1659 by 2212 pixels.
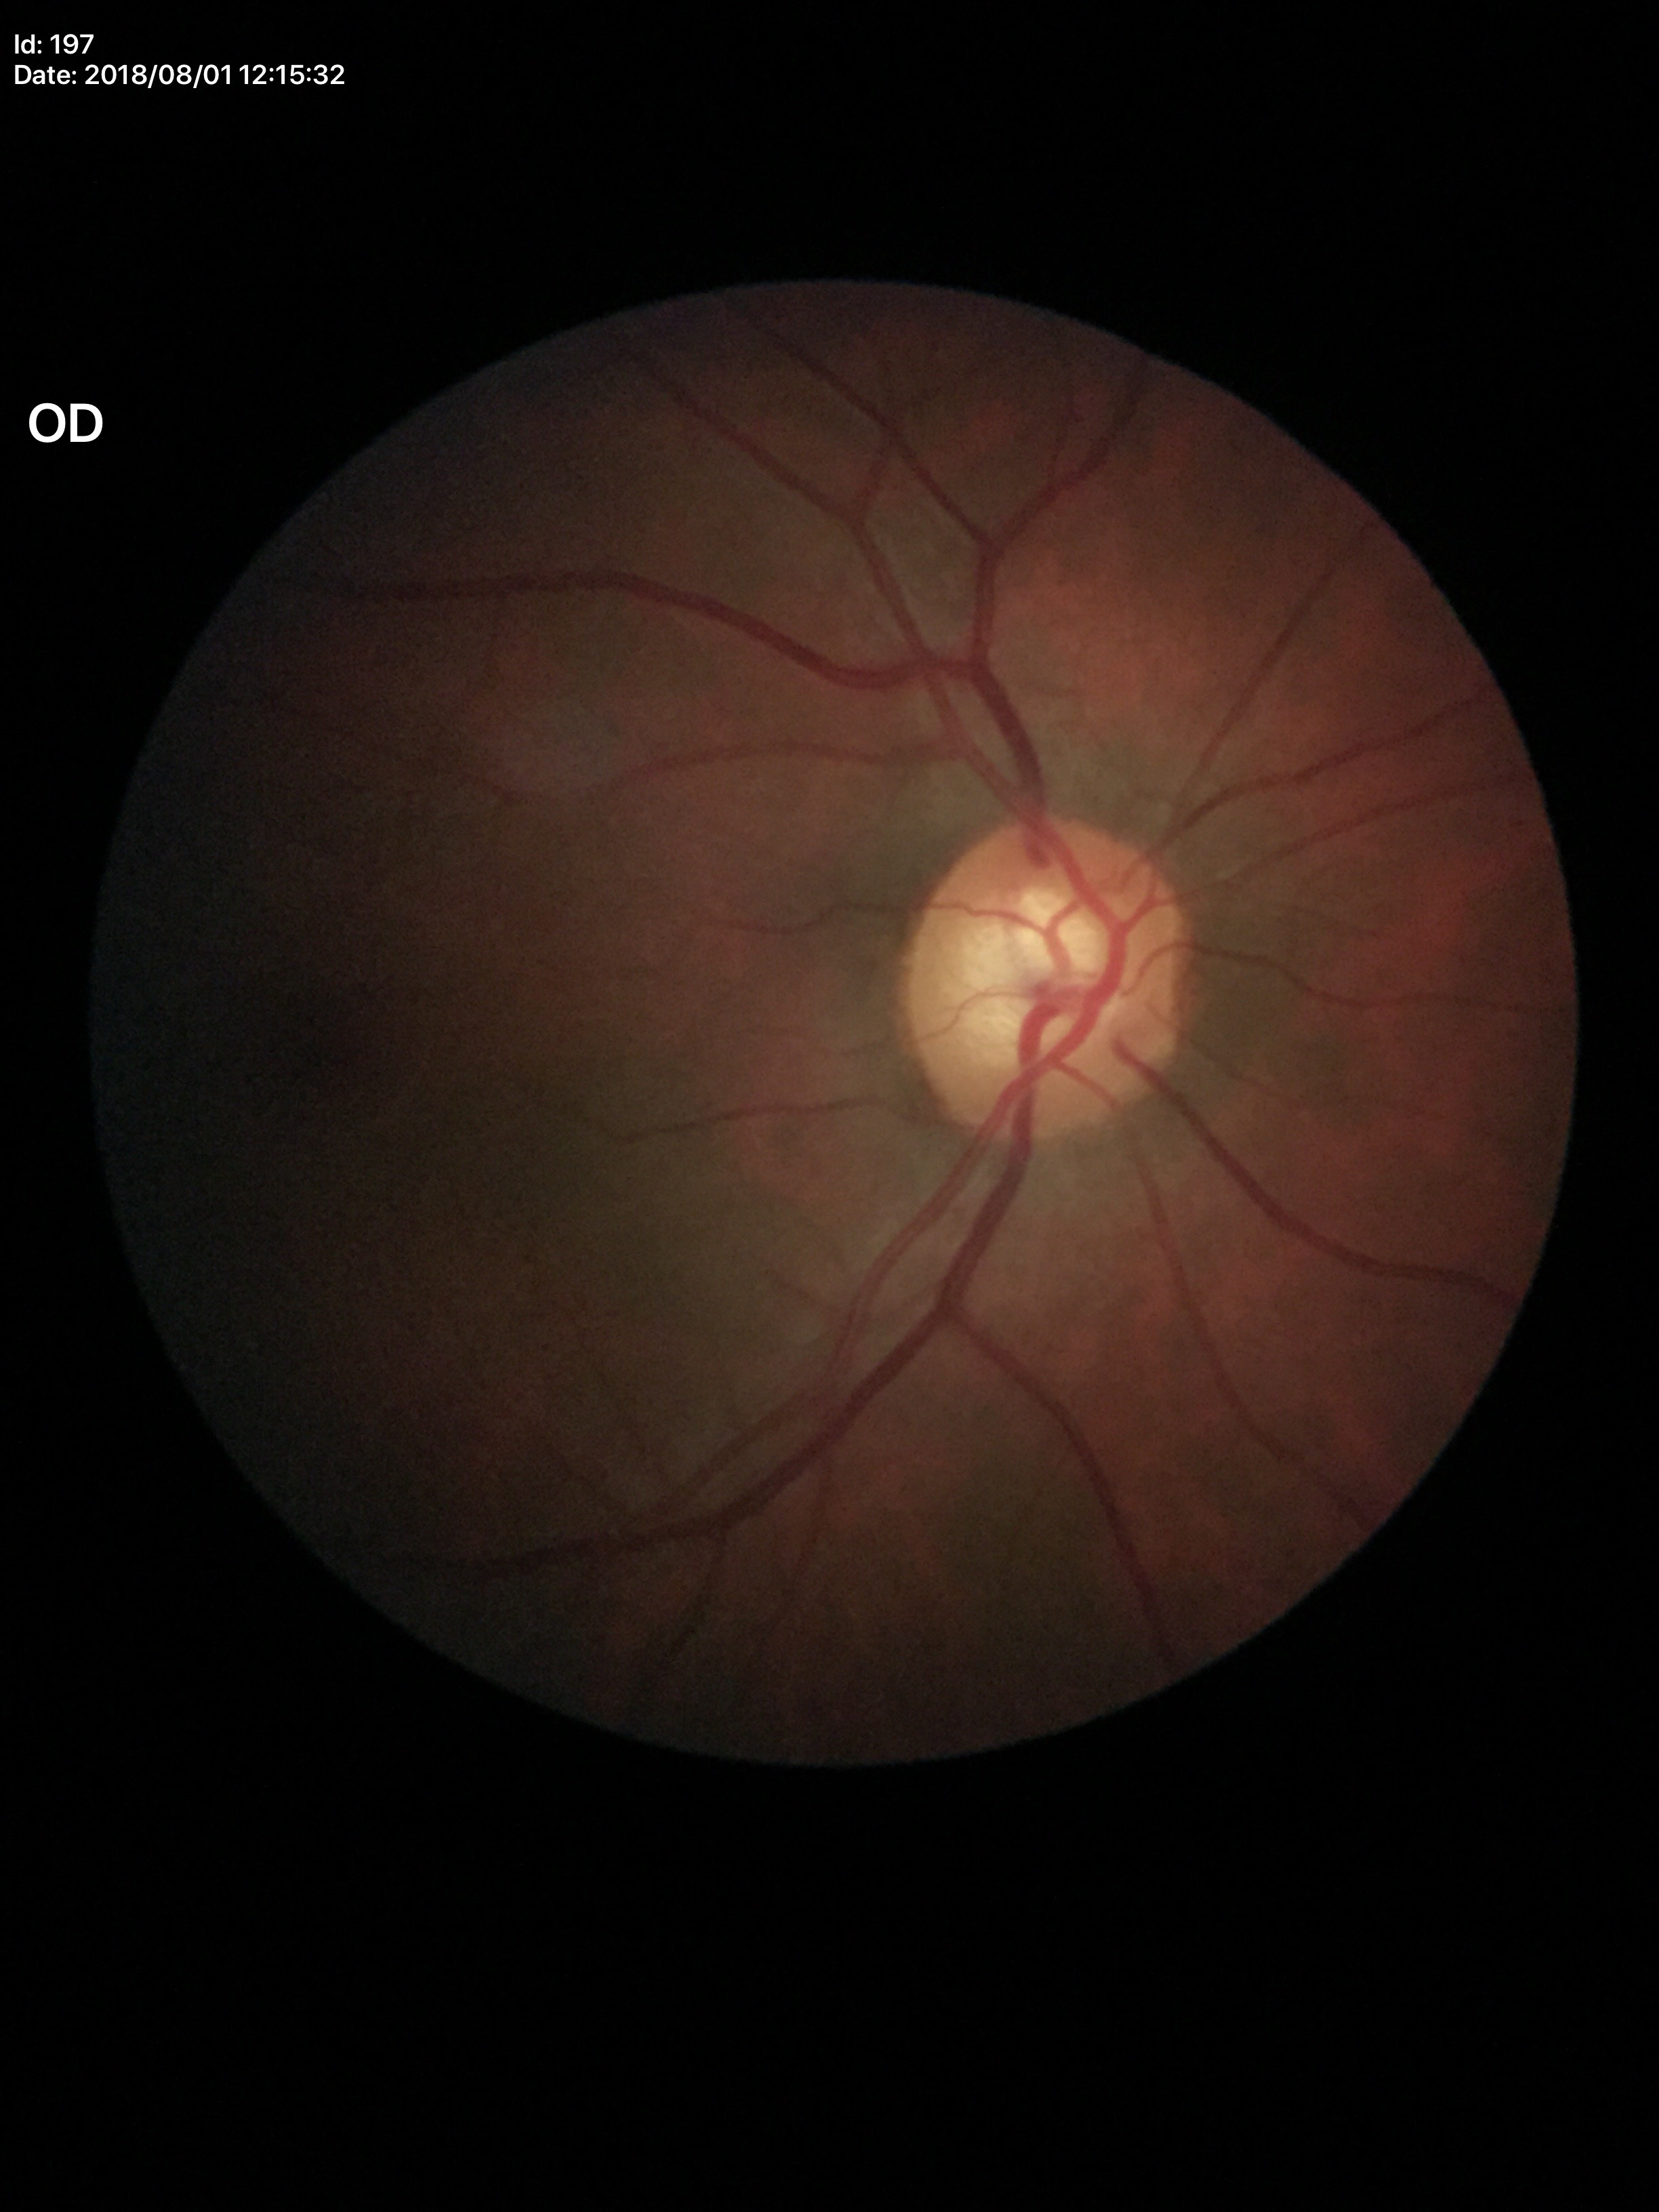
VCDR=0.64 | Glaucoma assessment=suspect (all 5 graders flagged glaucoma suspect)